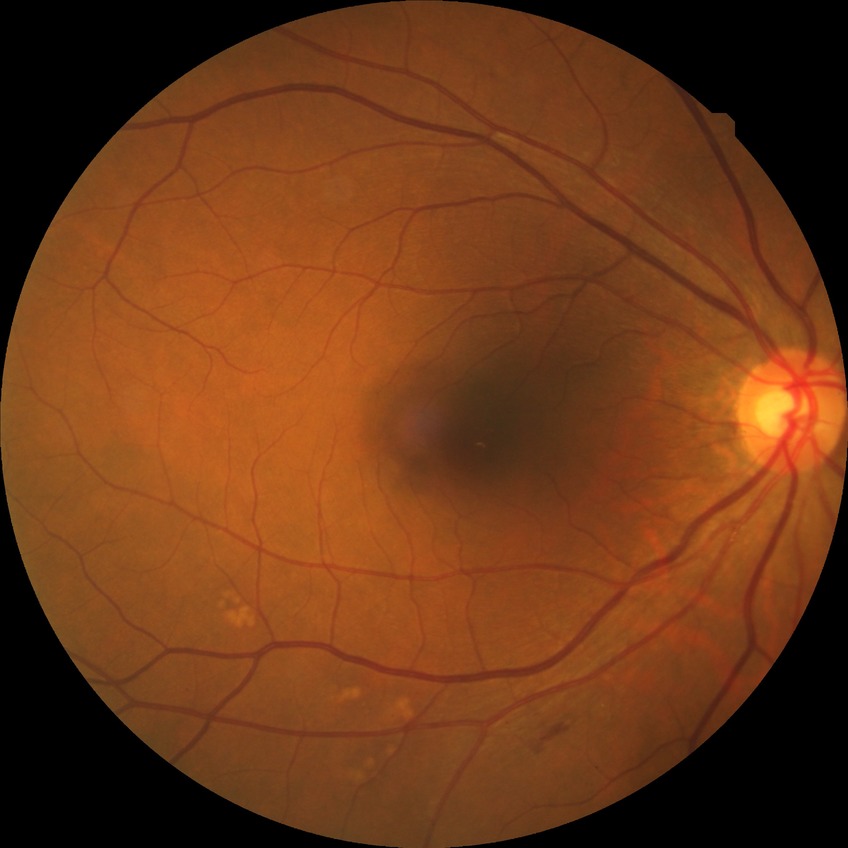

diabetic retinopathy (DR)@simple diabetic retinopathy (SDR).